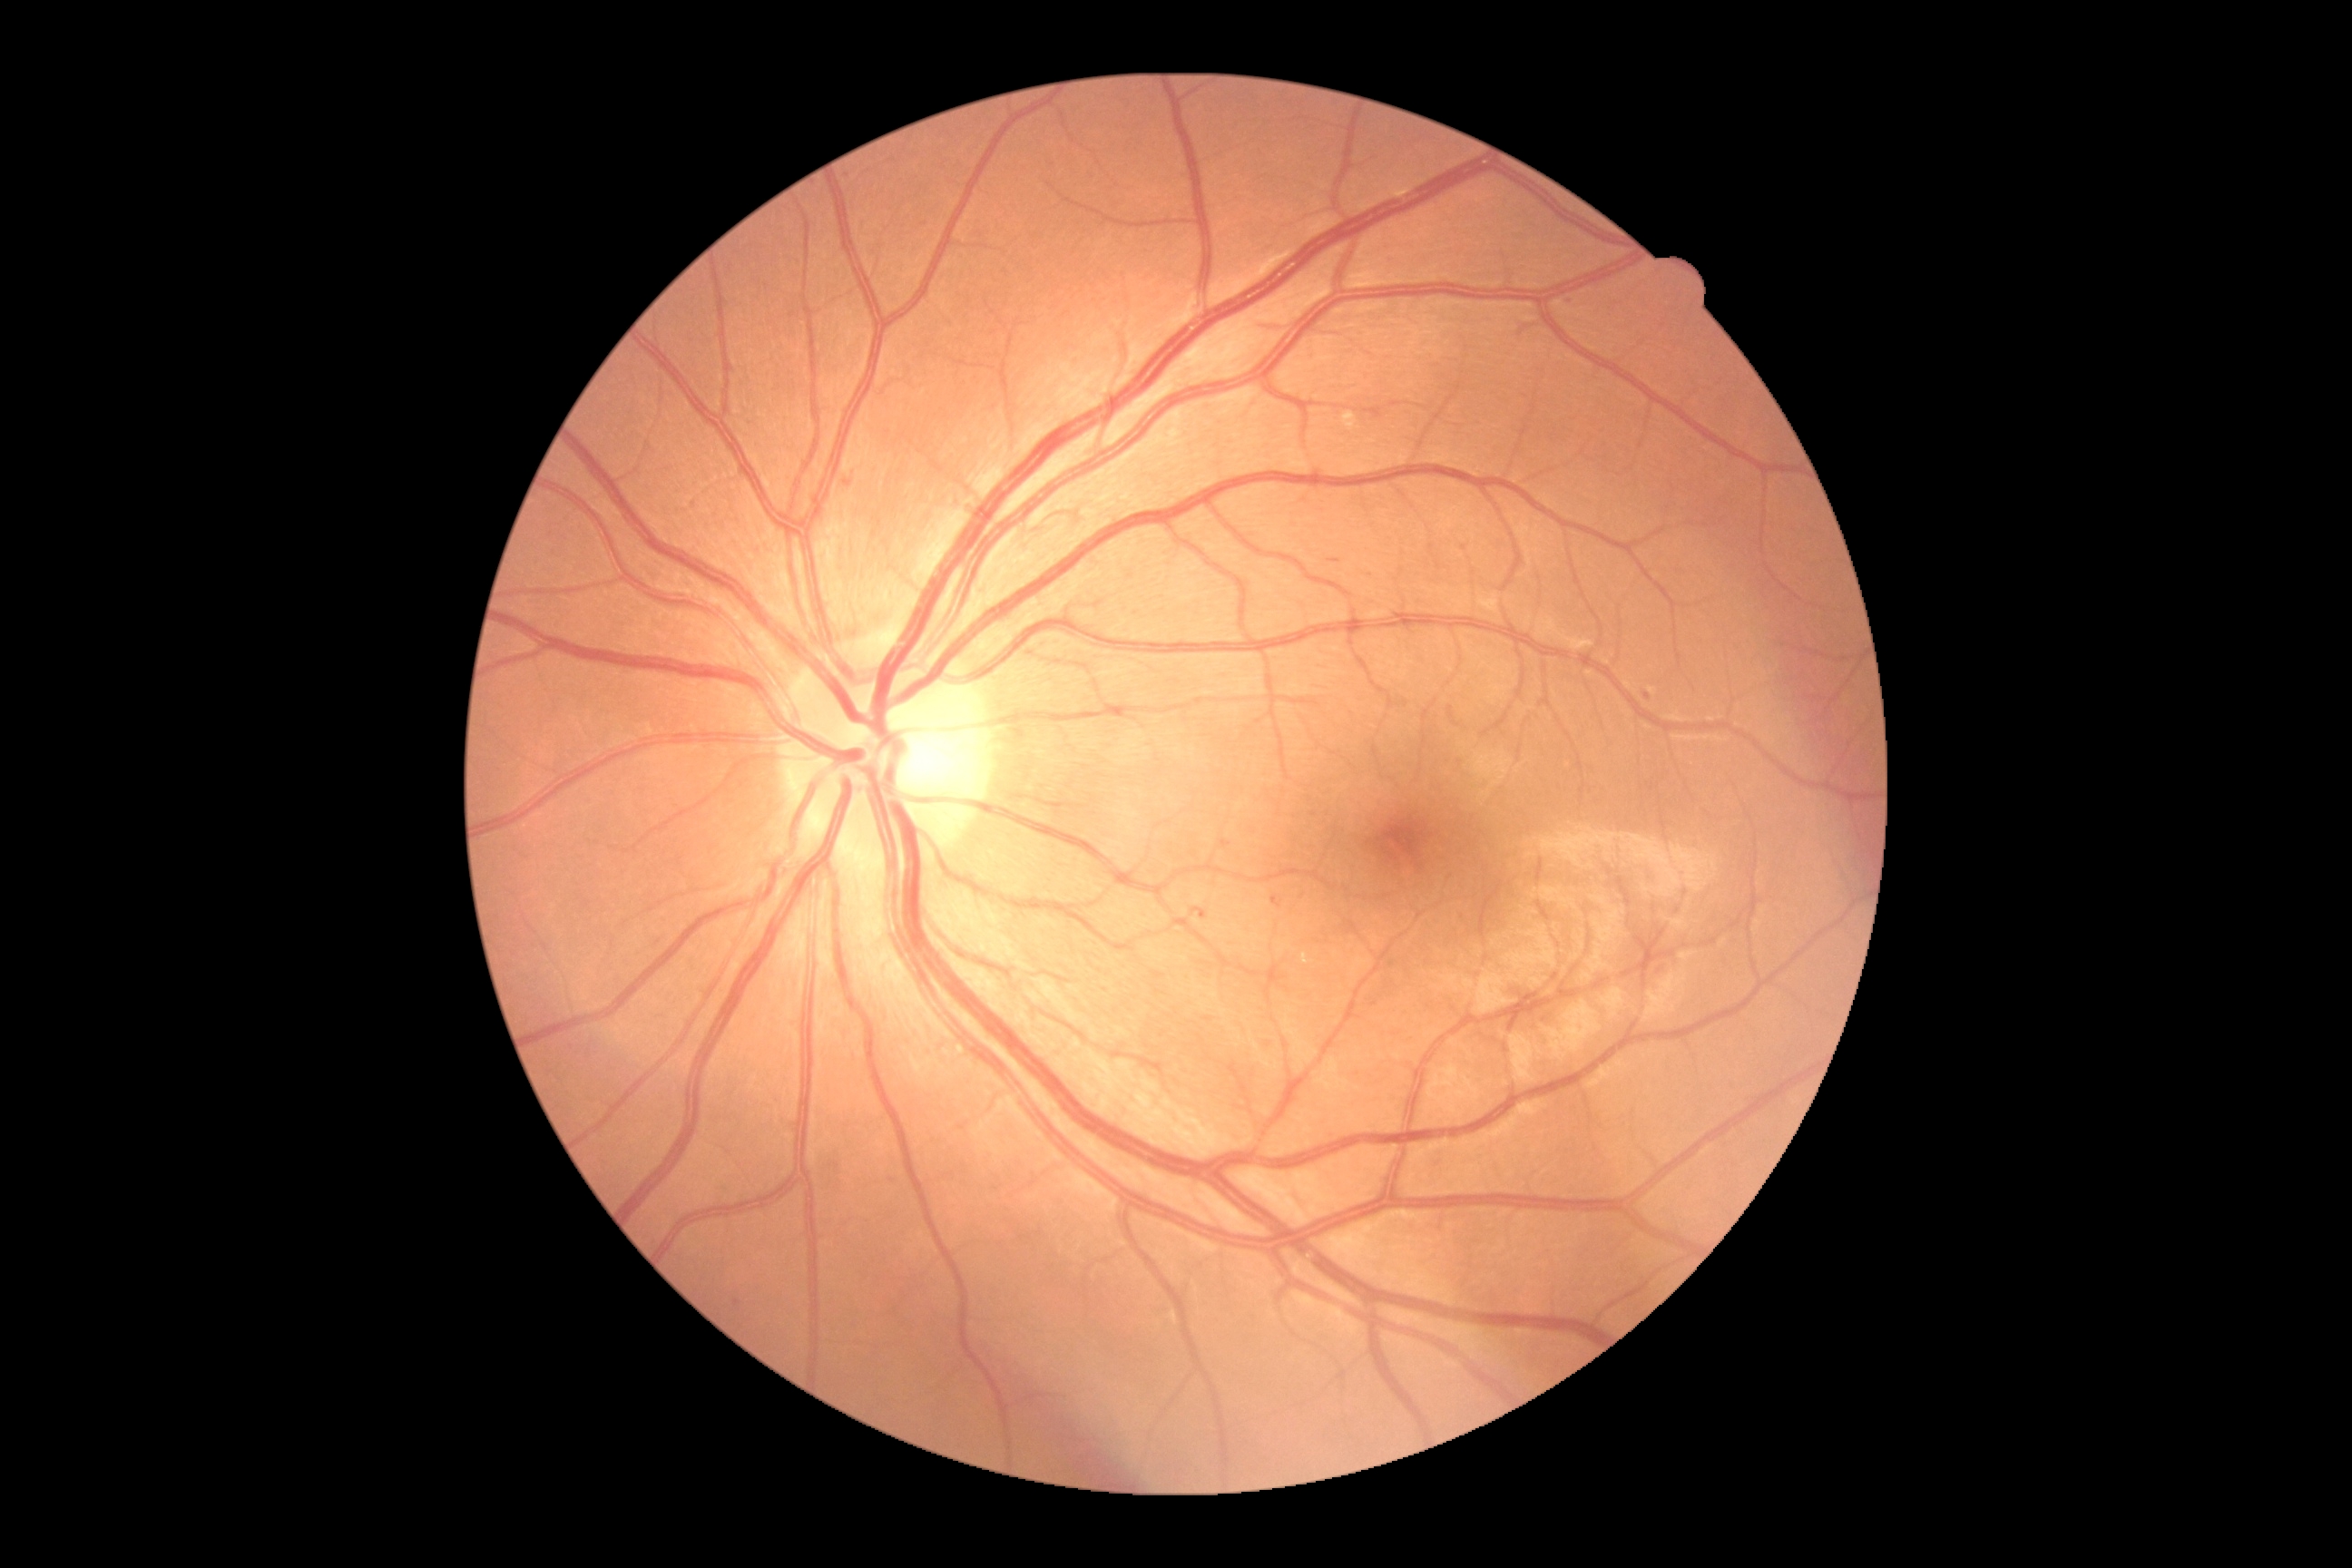 The retinopathy is classified as non-proliferative diabetic retinopathy.
Diabetic retinopathy severity: grade 2 (moderate NPDR).